Retinal fundus photograph, 45-degree field of view:
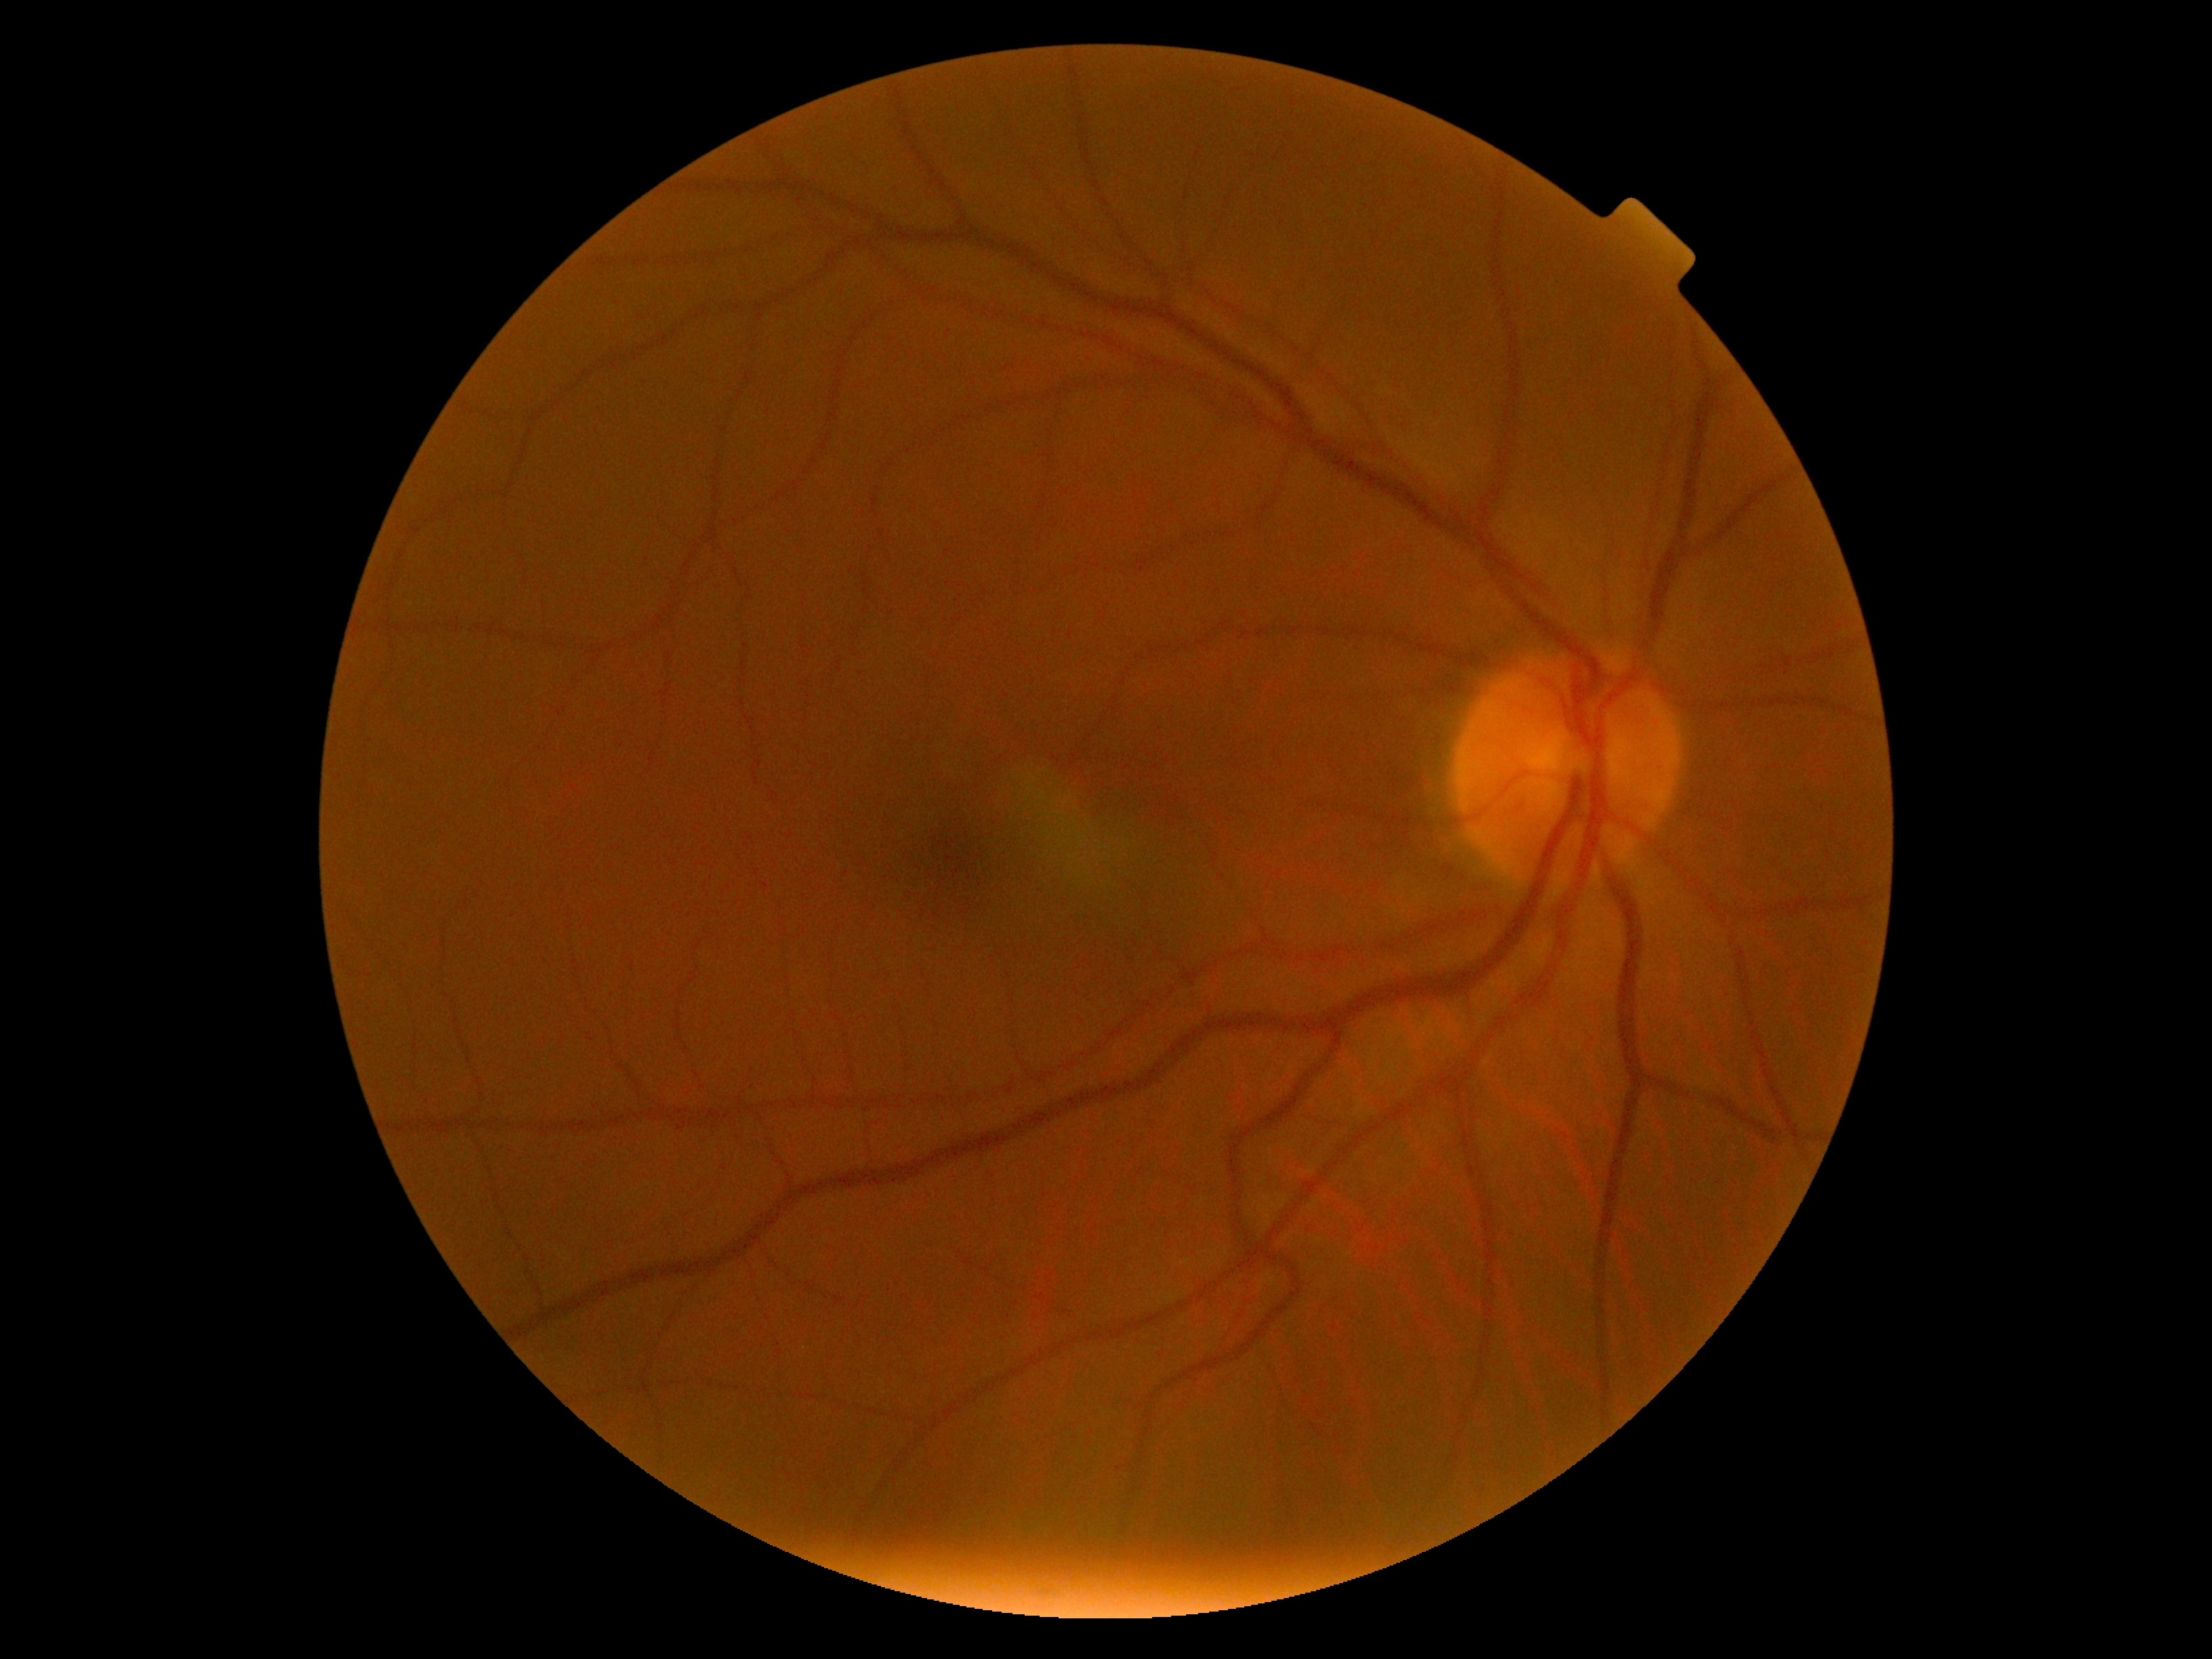
diabetic retinopathy (DR): 0/4 — no visible signs of diabetic retinopathy.